45° field of view; Davis DR grading: 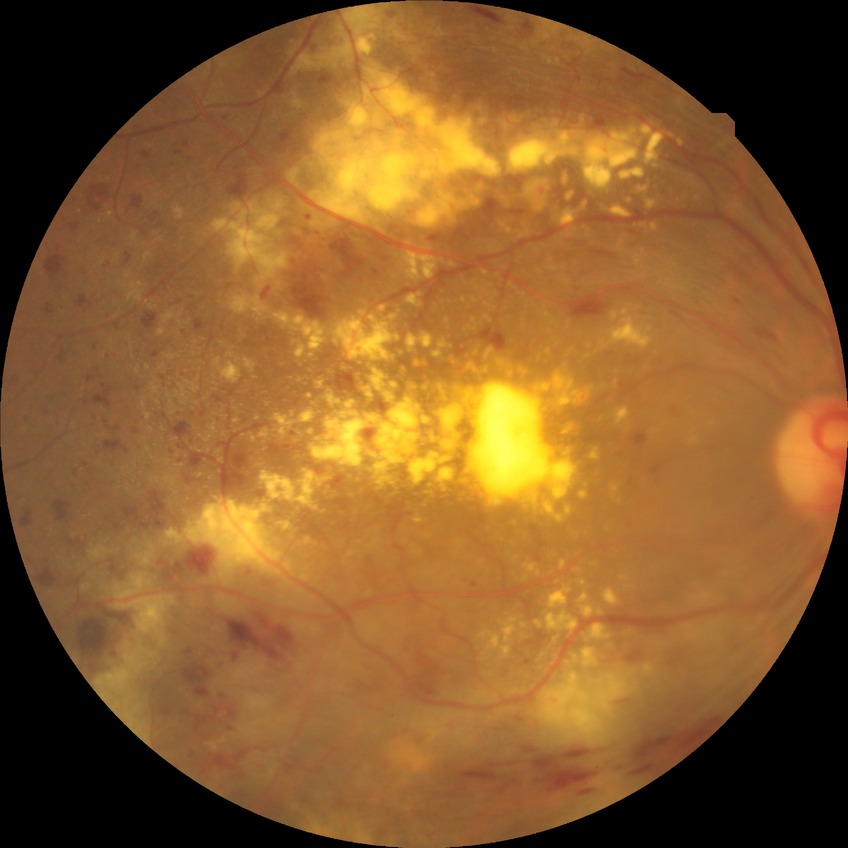

* diabetic retinopathy (DR): proliferative diabetic retinopathy (PDR)